Acquired on the Natus RetCam Envision; pediatric retinal photograph (wide-field).
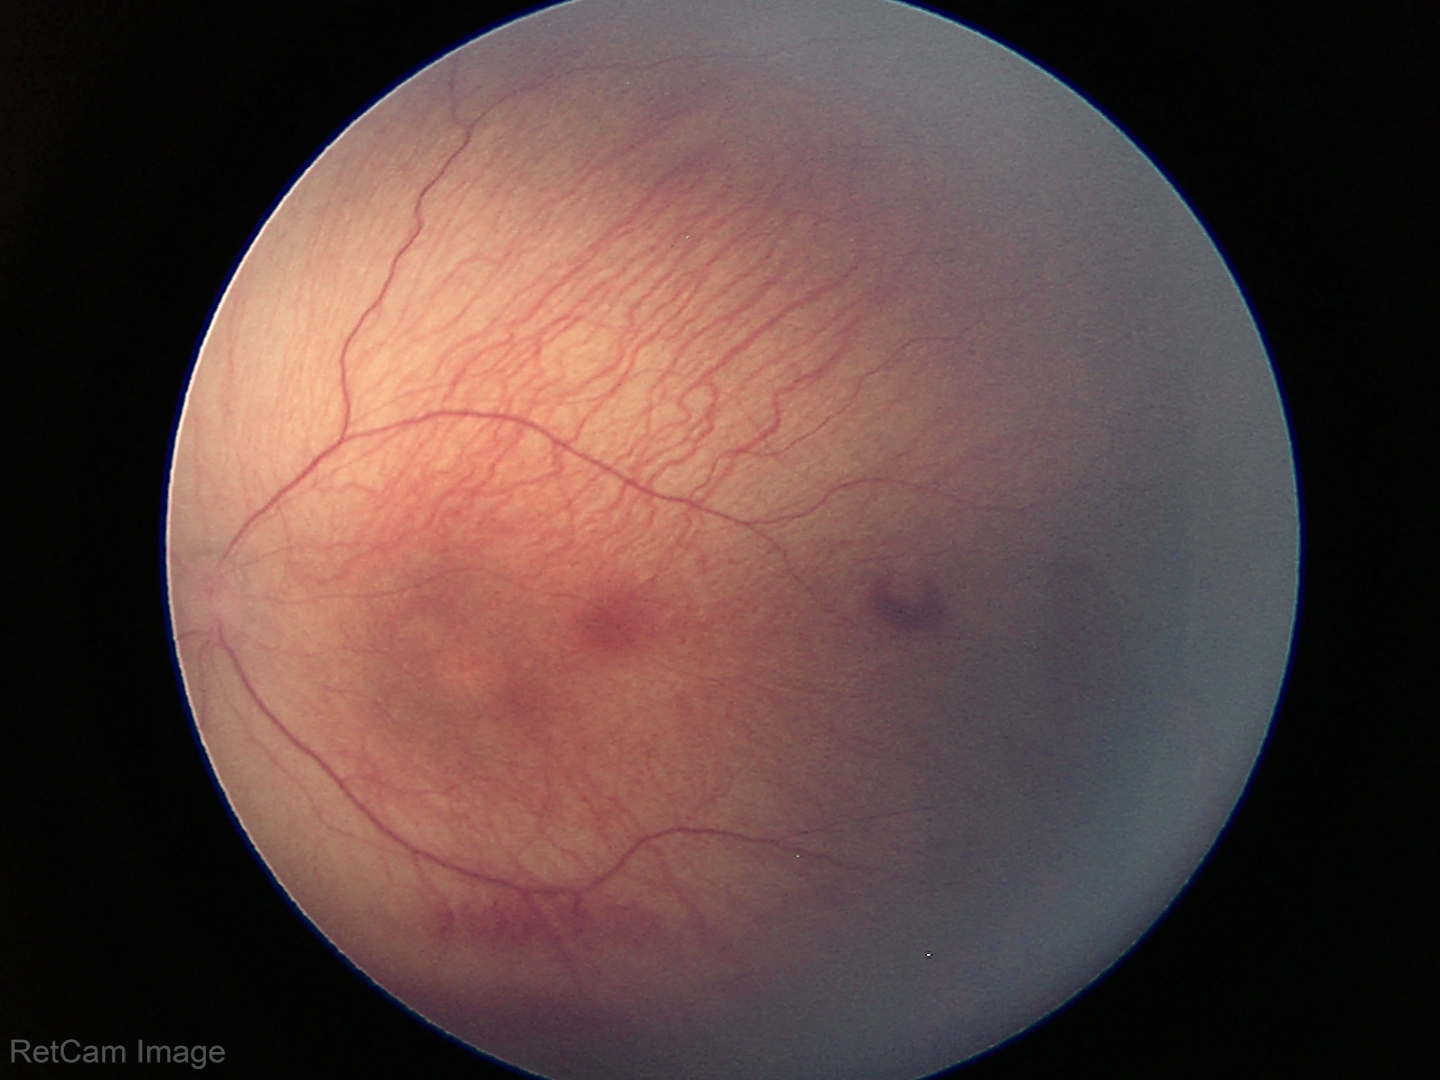

Examination diagnosed as retinopathy of prematurity stage 1. Without plus disease.